640 x 480 pixels; Clarity RetCam 3, 130° FOV; infant wide-field retinal image.
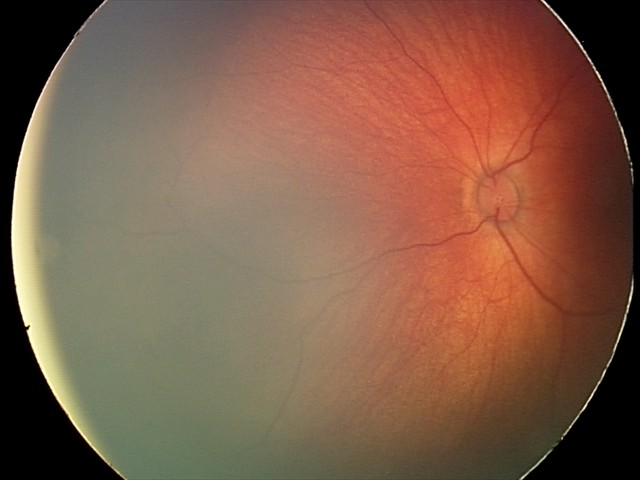
Screening: retinal hemorrhages.